2048 x 1536 pixels:
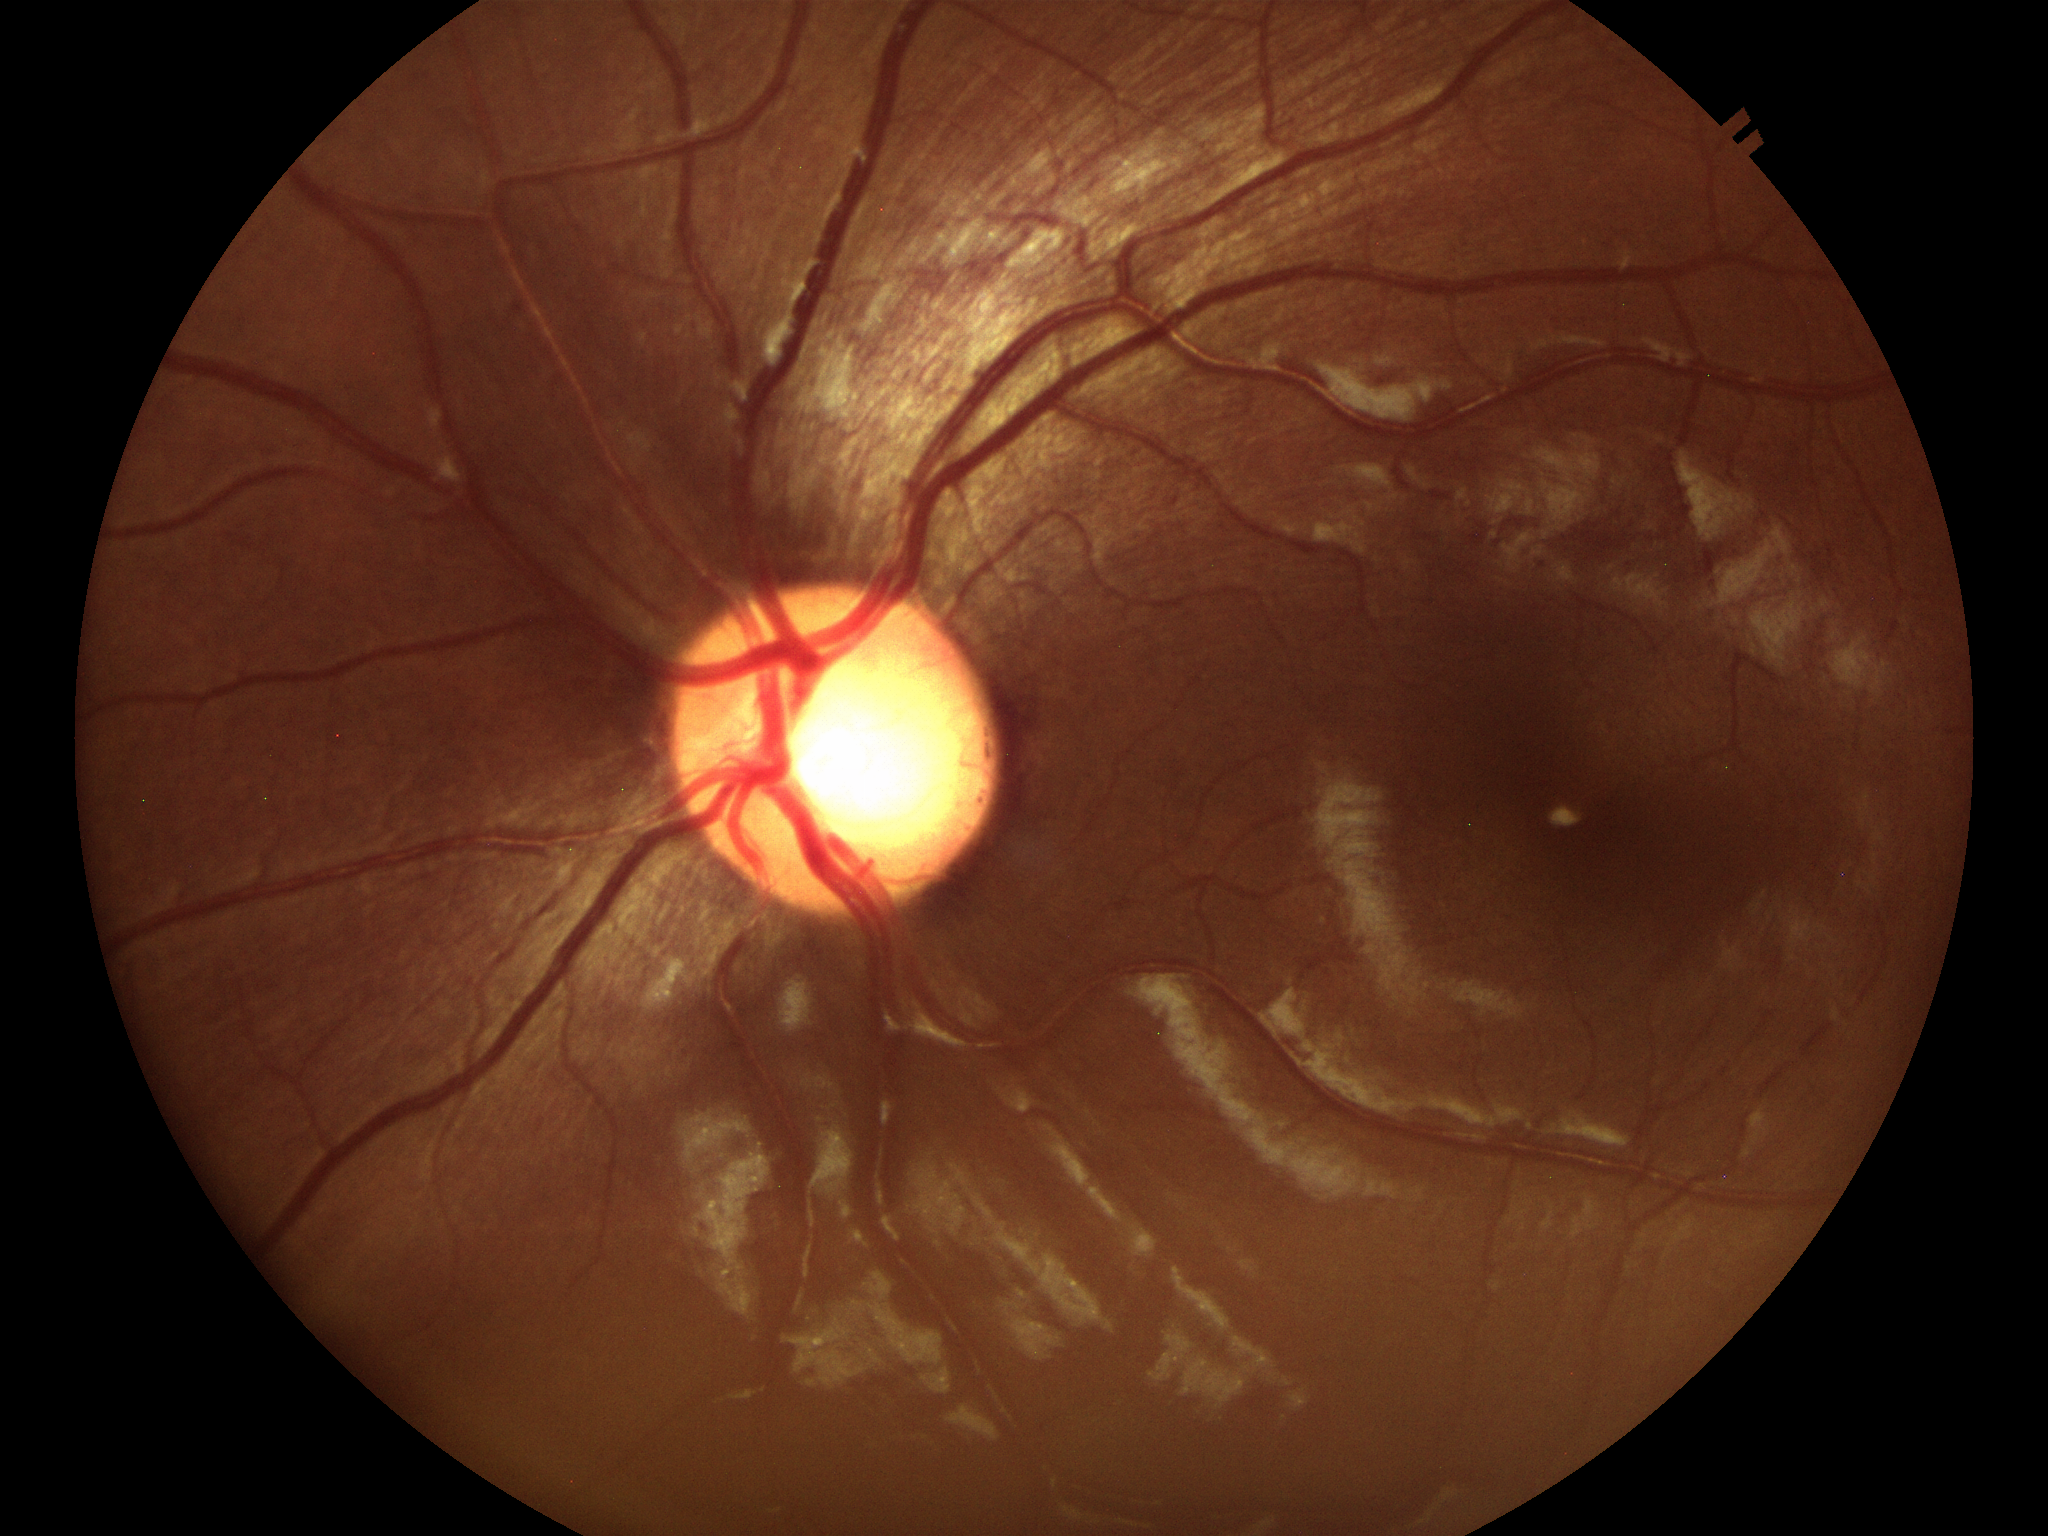
Findings suspicious for glaucoma.
Horizontal cup-disc ratio (HCDR) is 0.67.
Vertical CDR (VCDR): 0.61.